Macula at the center of the field, 50° field of view.
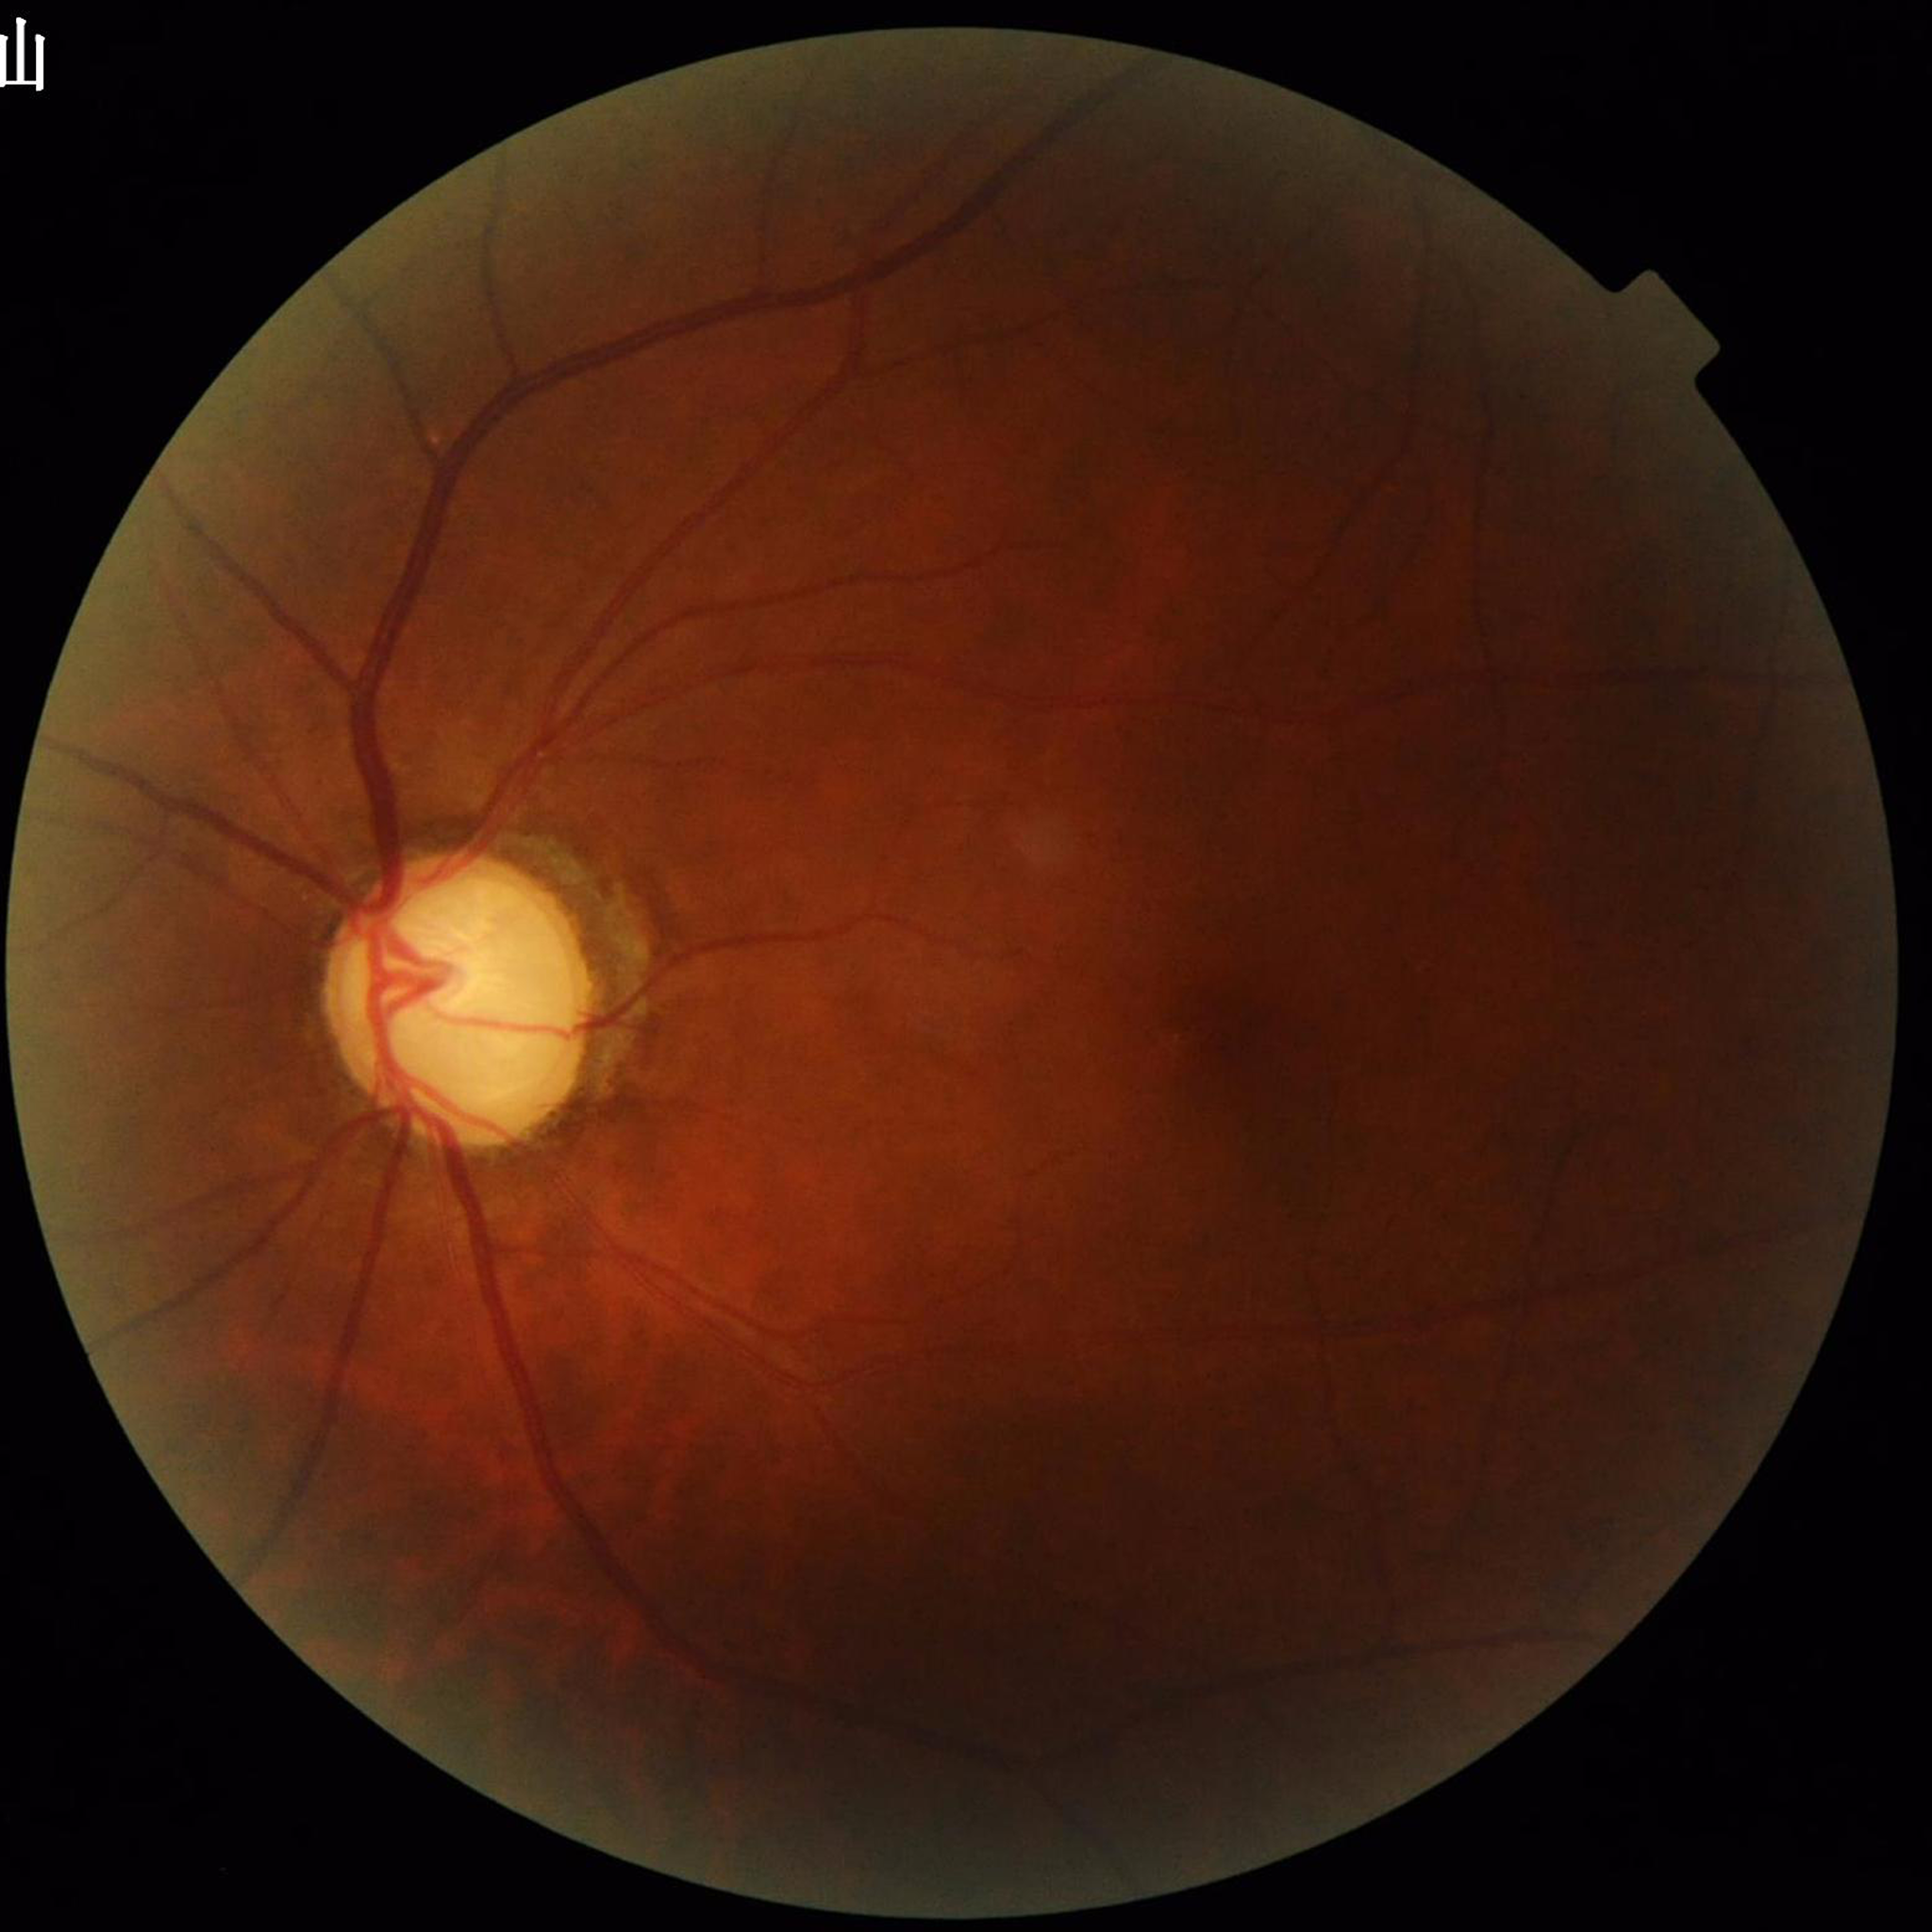 Color fundus photograph from a patient diagnosed with glaucoma. Quality: concerns include illumination/color distortion.